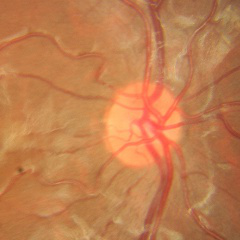
Findings consistent with no evidence of glaucoma.